CFP: 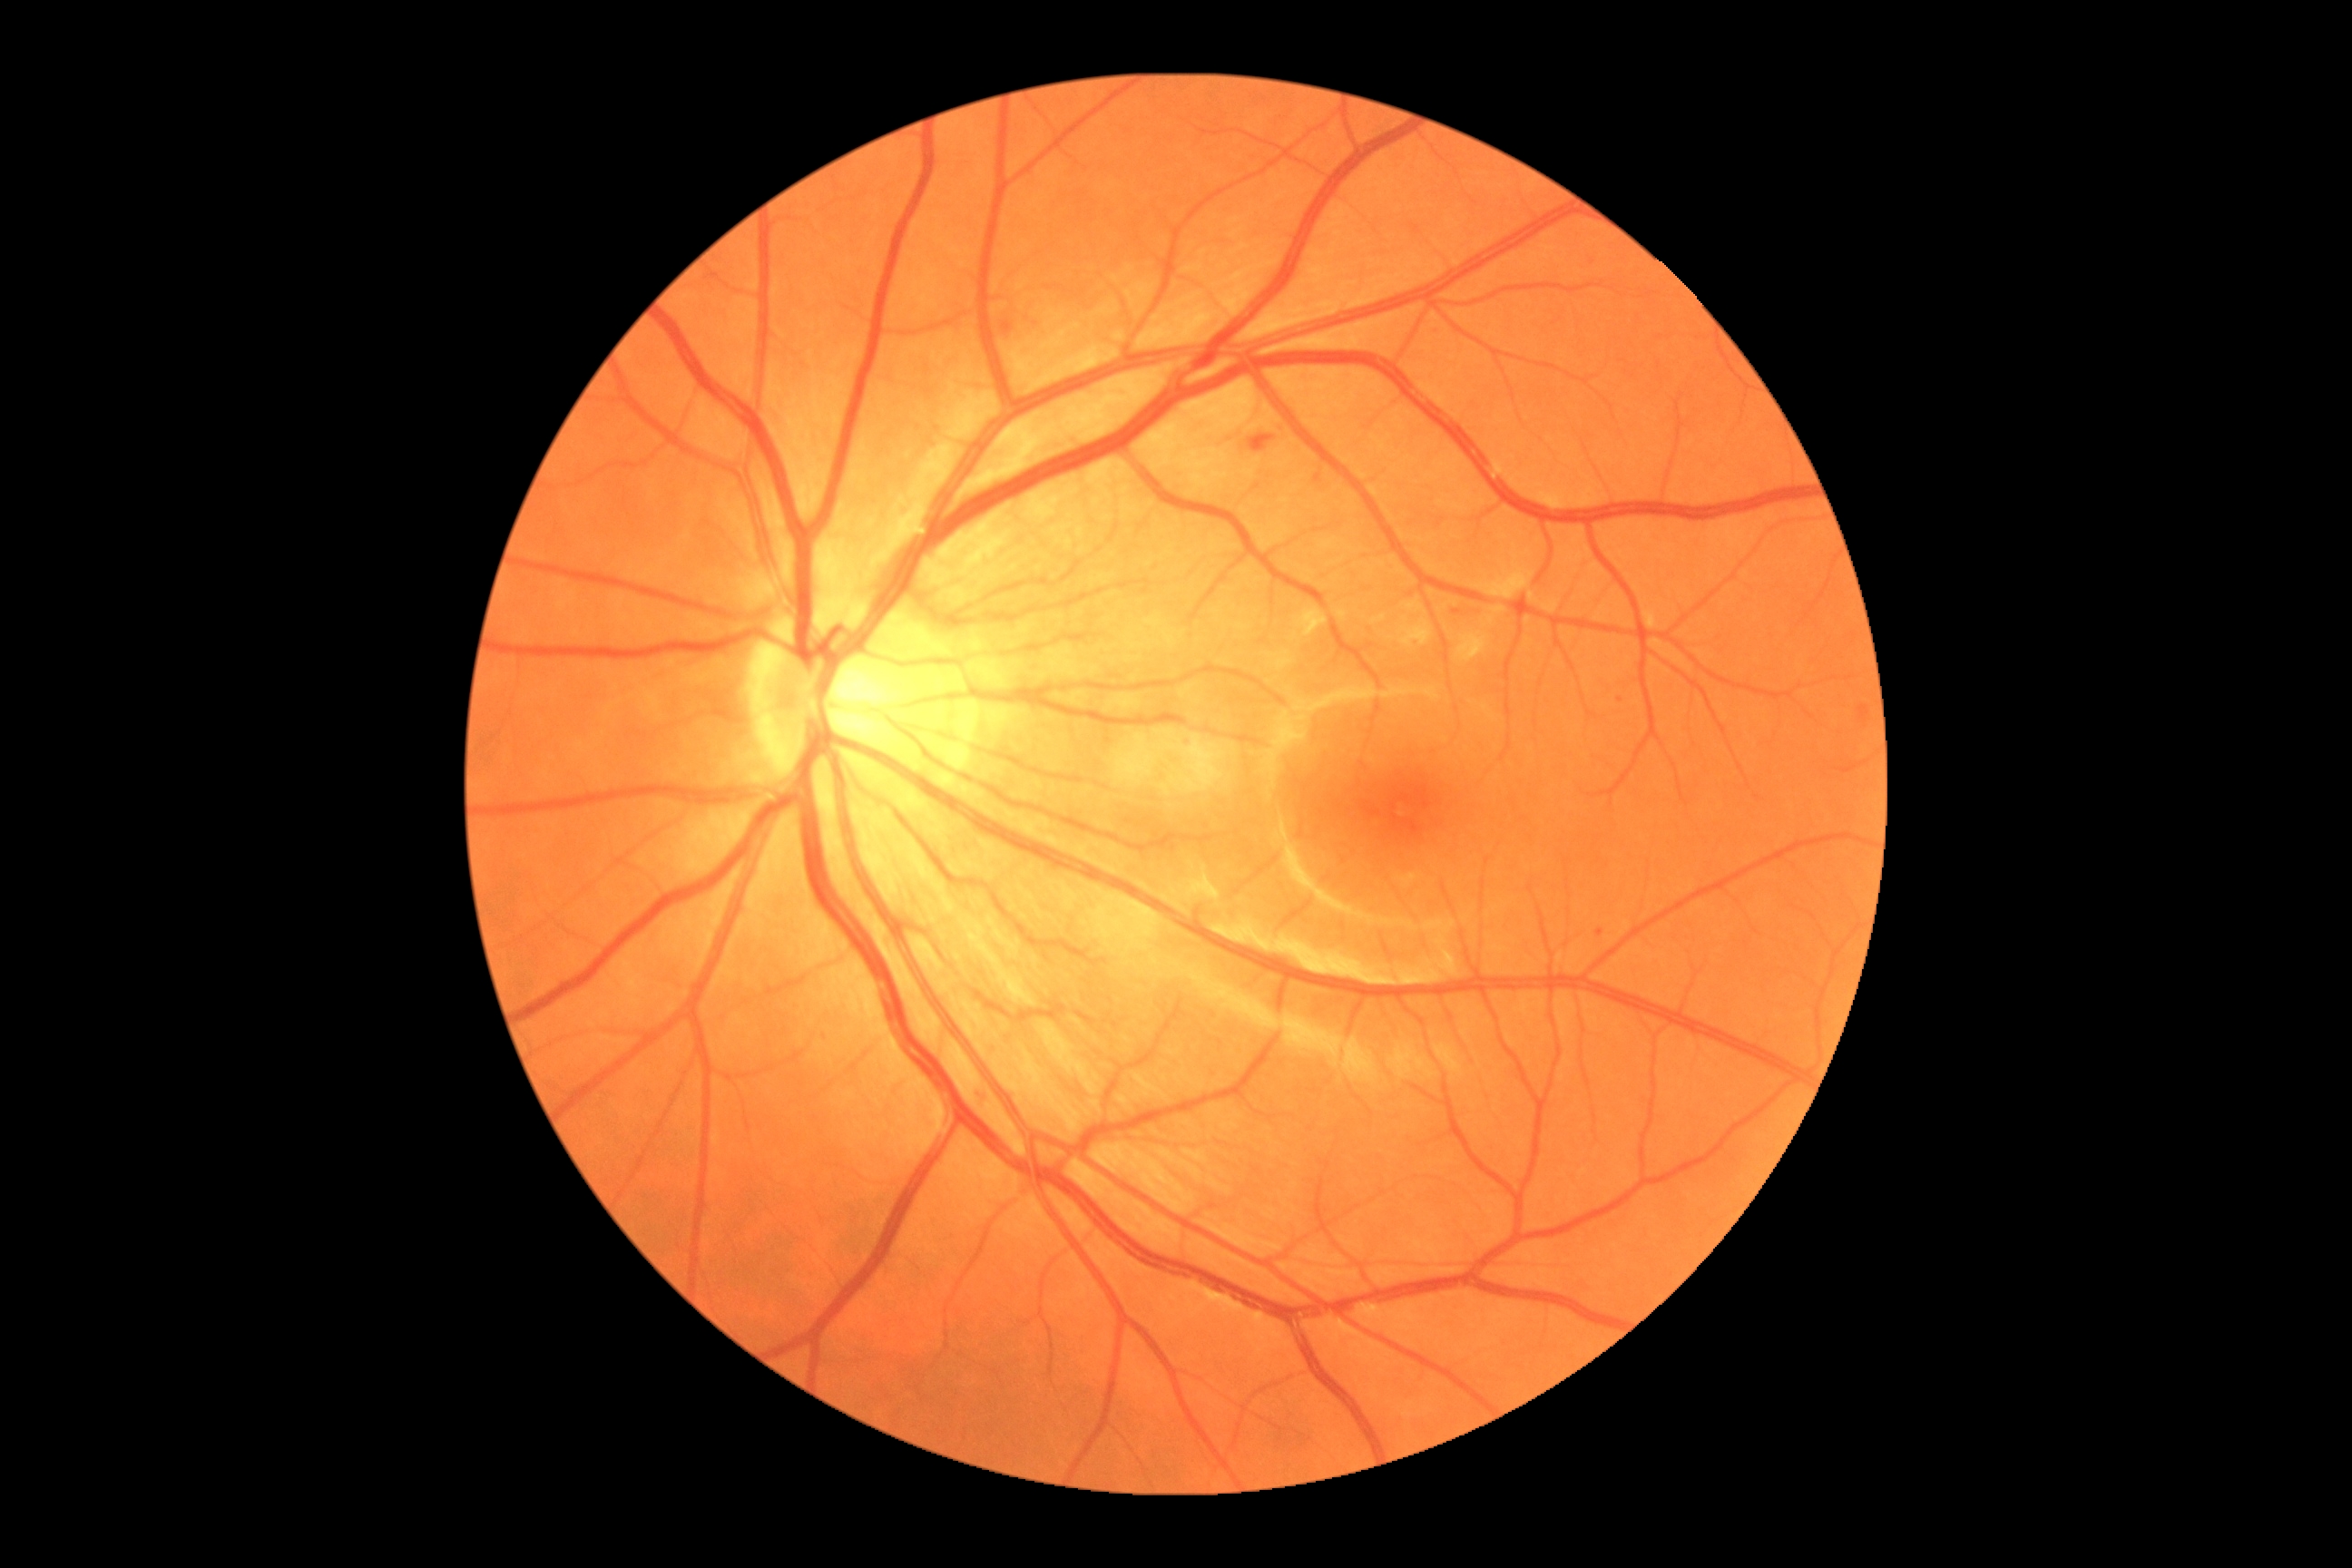 diabetic retinopathy: moderate non-proliferative diabetic retinopathy (grade 2).